45 degree fundus photograph, modified Davis grading.
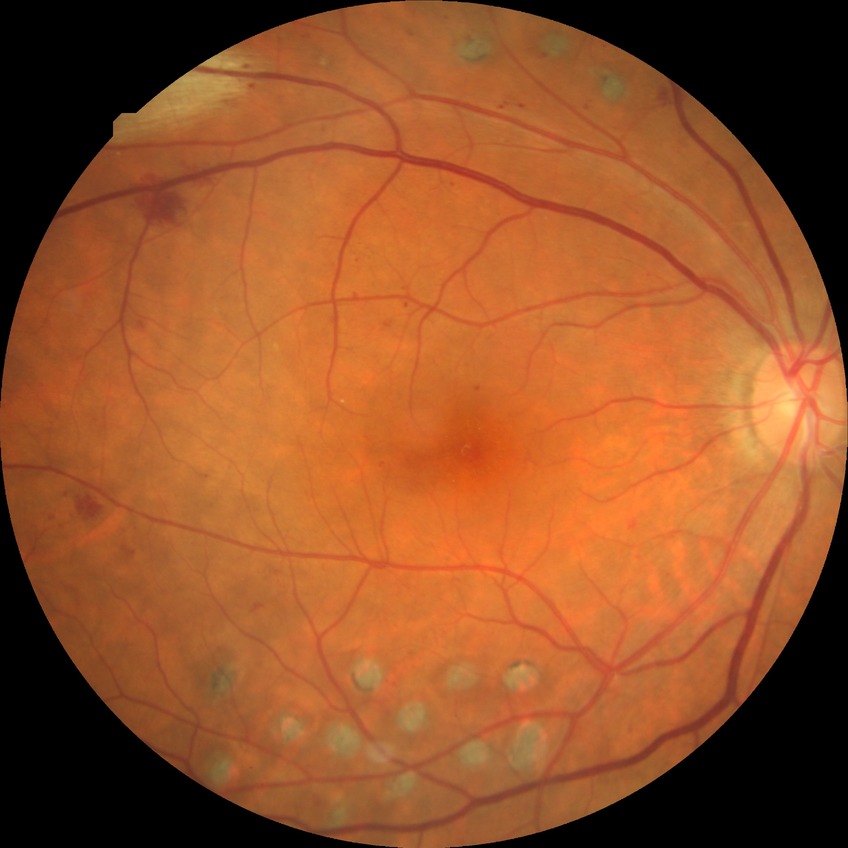
diabetic retinopathy (DR): PDR (proliferative diabetic retinopathy).